Captured on a Remidio Fundus on Phone: 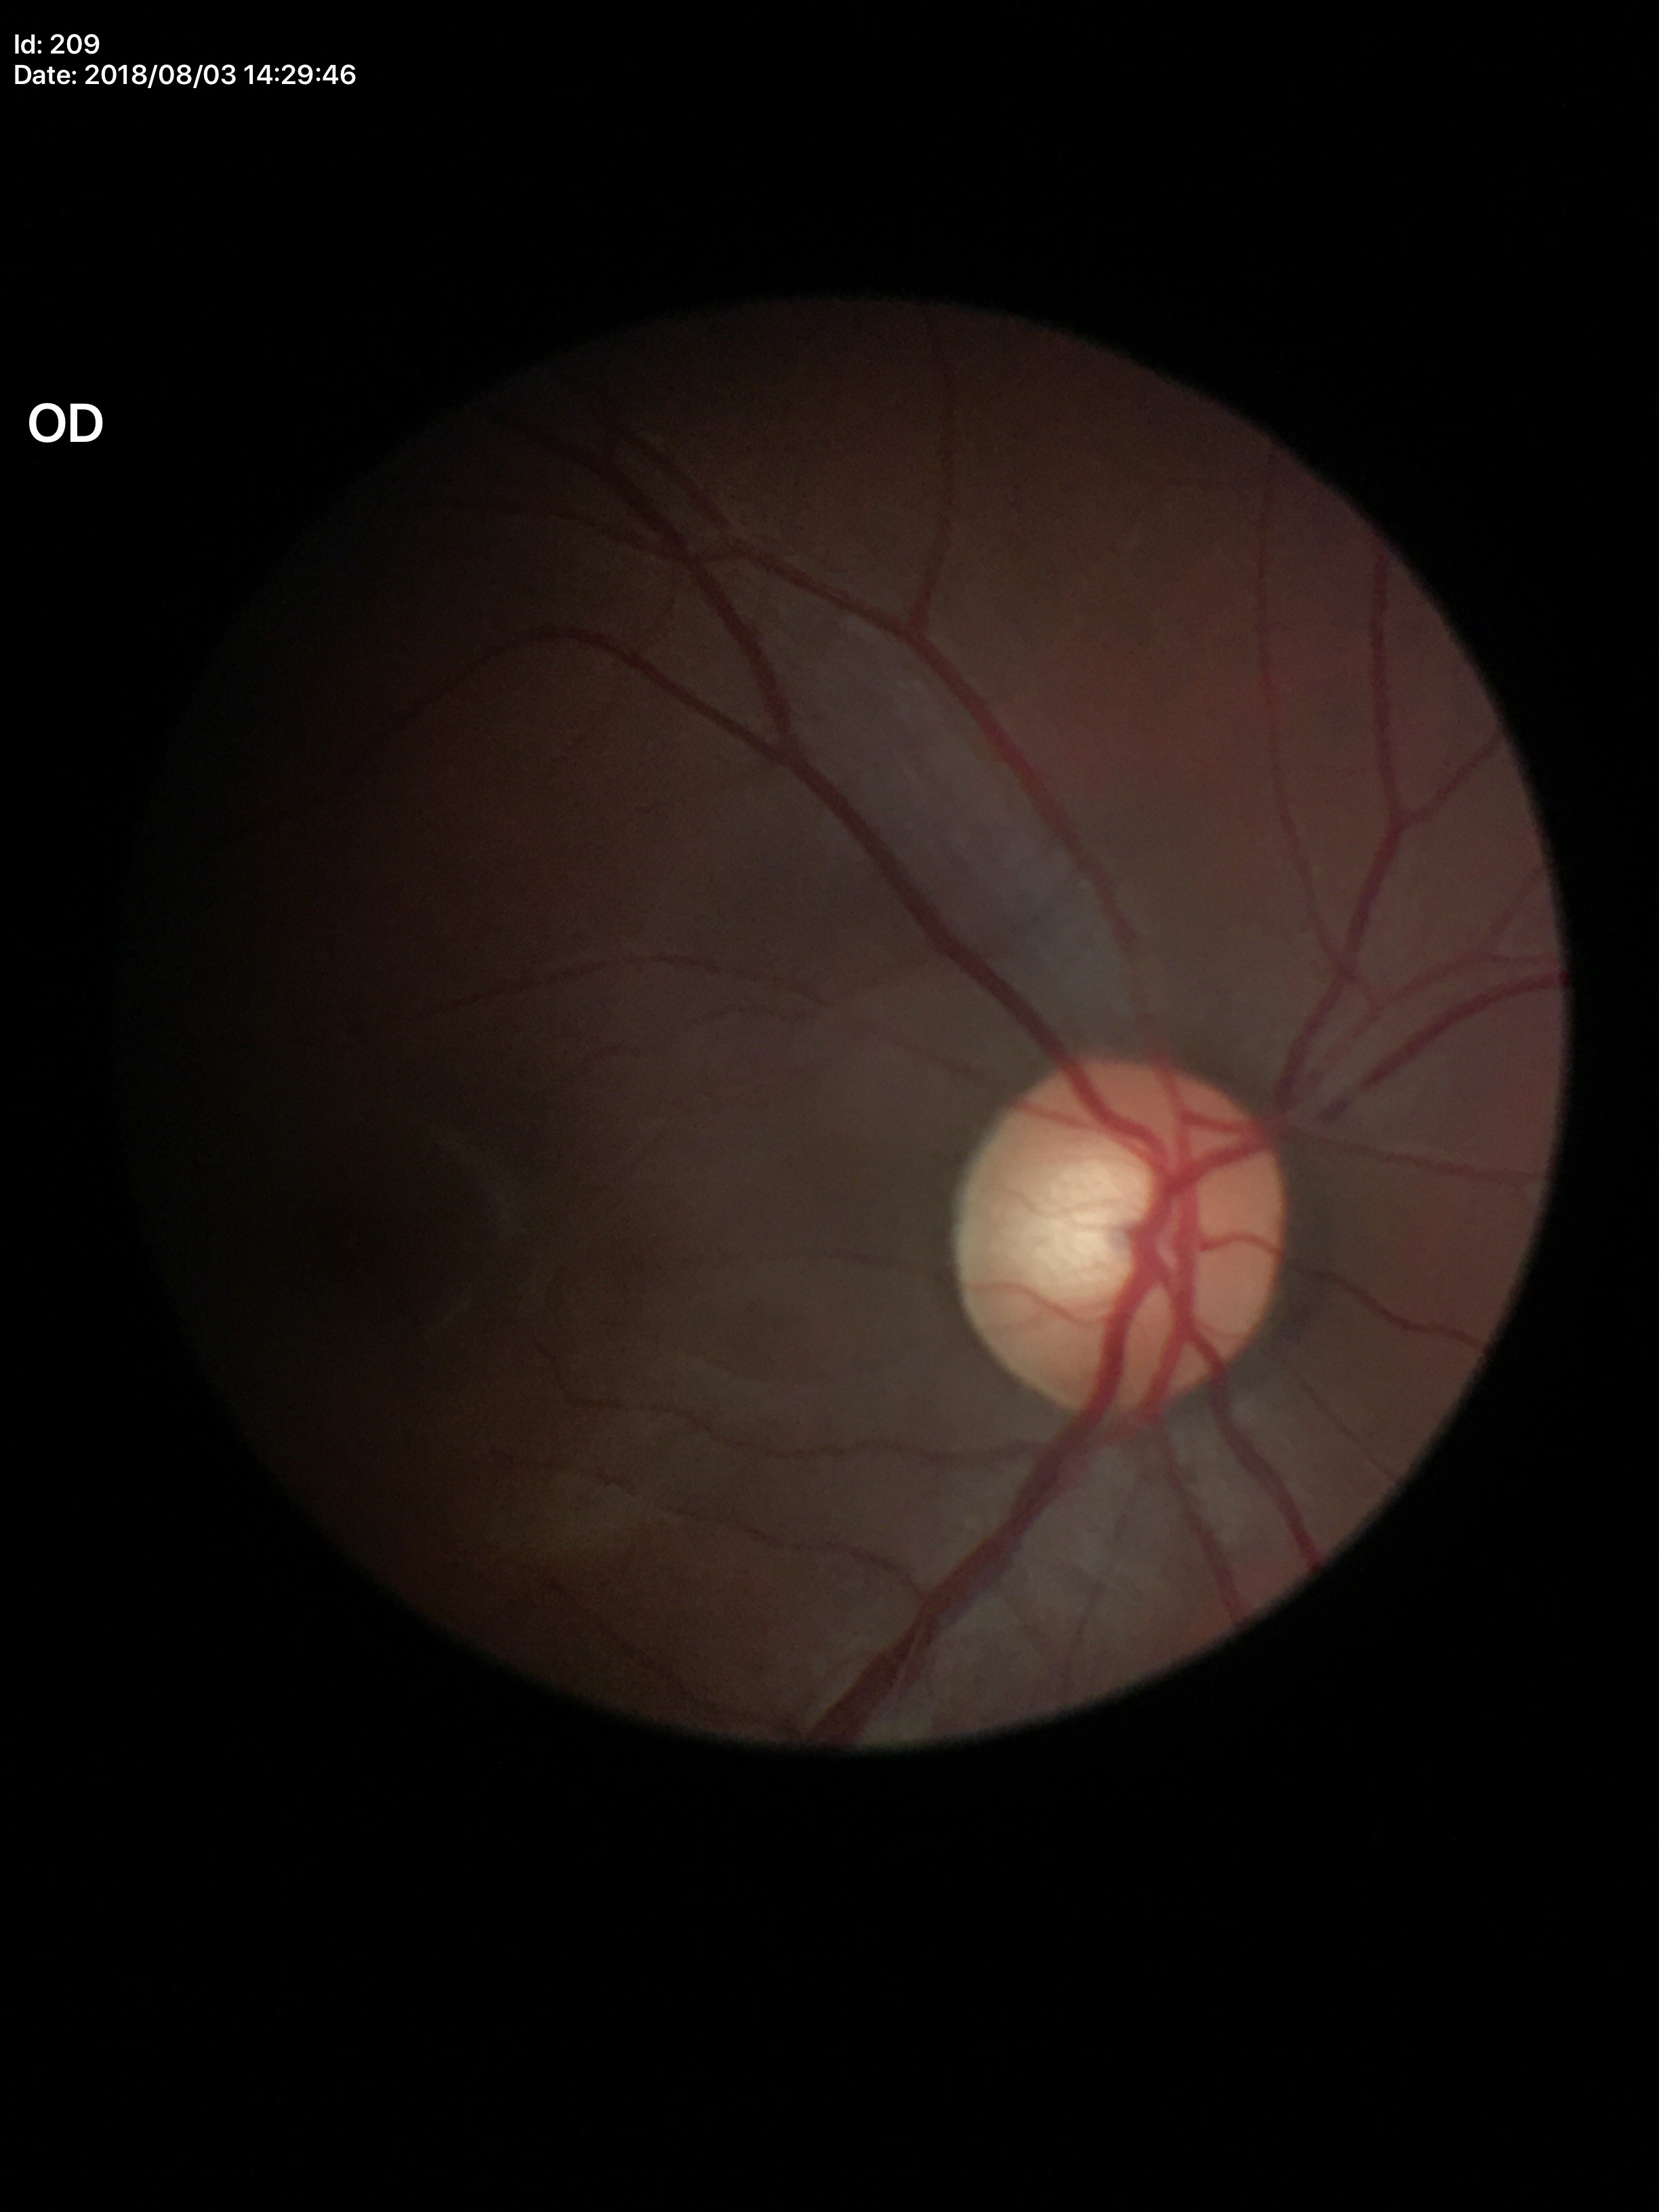
Glaucoma decision: suspicious. Vertical CDR (VCDR) is 0.58.